Image size 848x848, retinal fundus photograph — 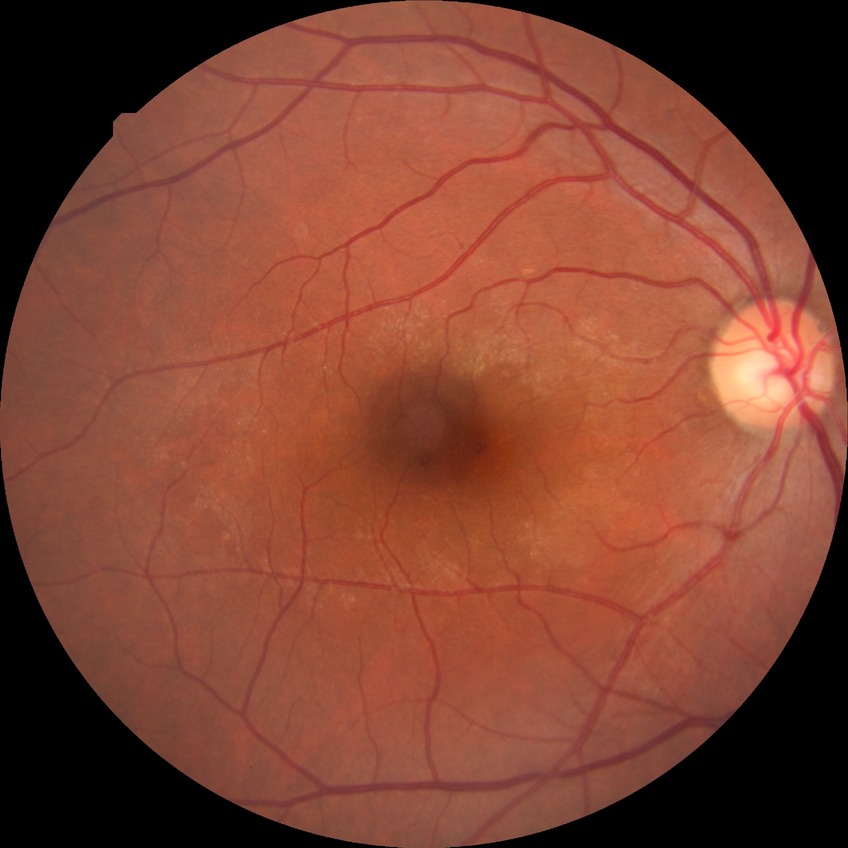

No apparent diabetic retinopathy. Modified Davis grade: NDR.